FOV: 45 degrees · retinal fundus photograph.
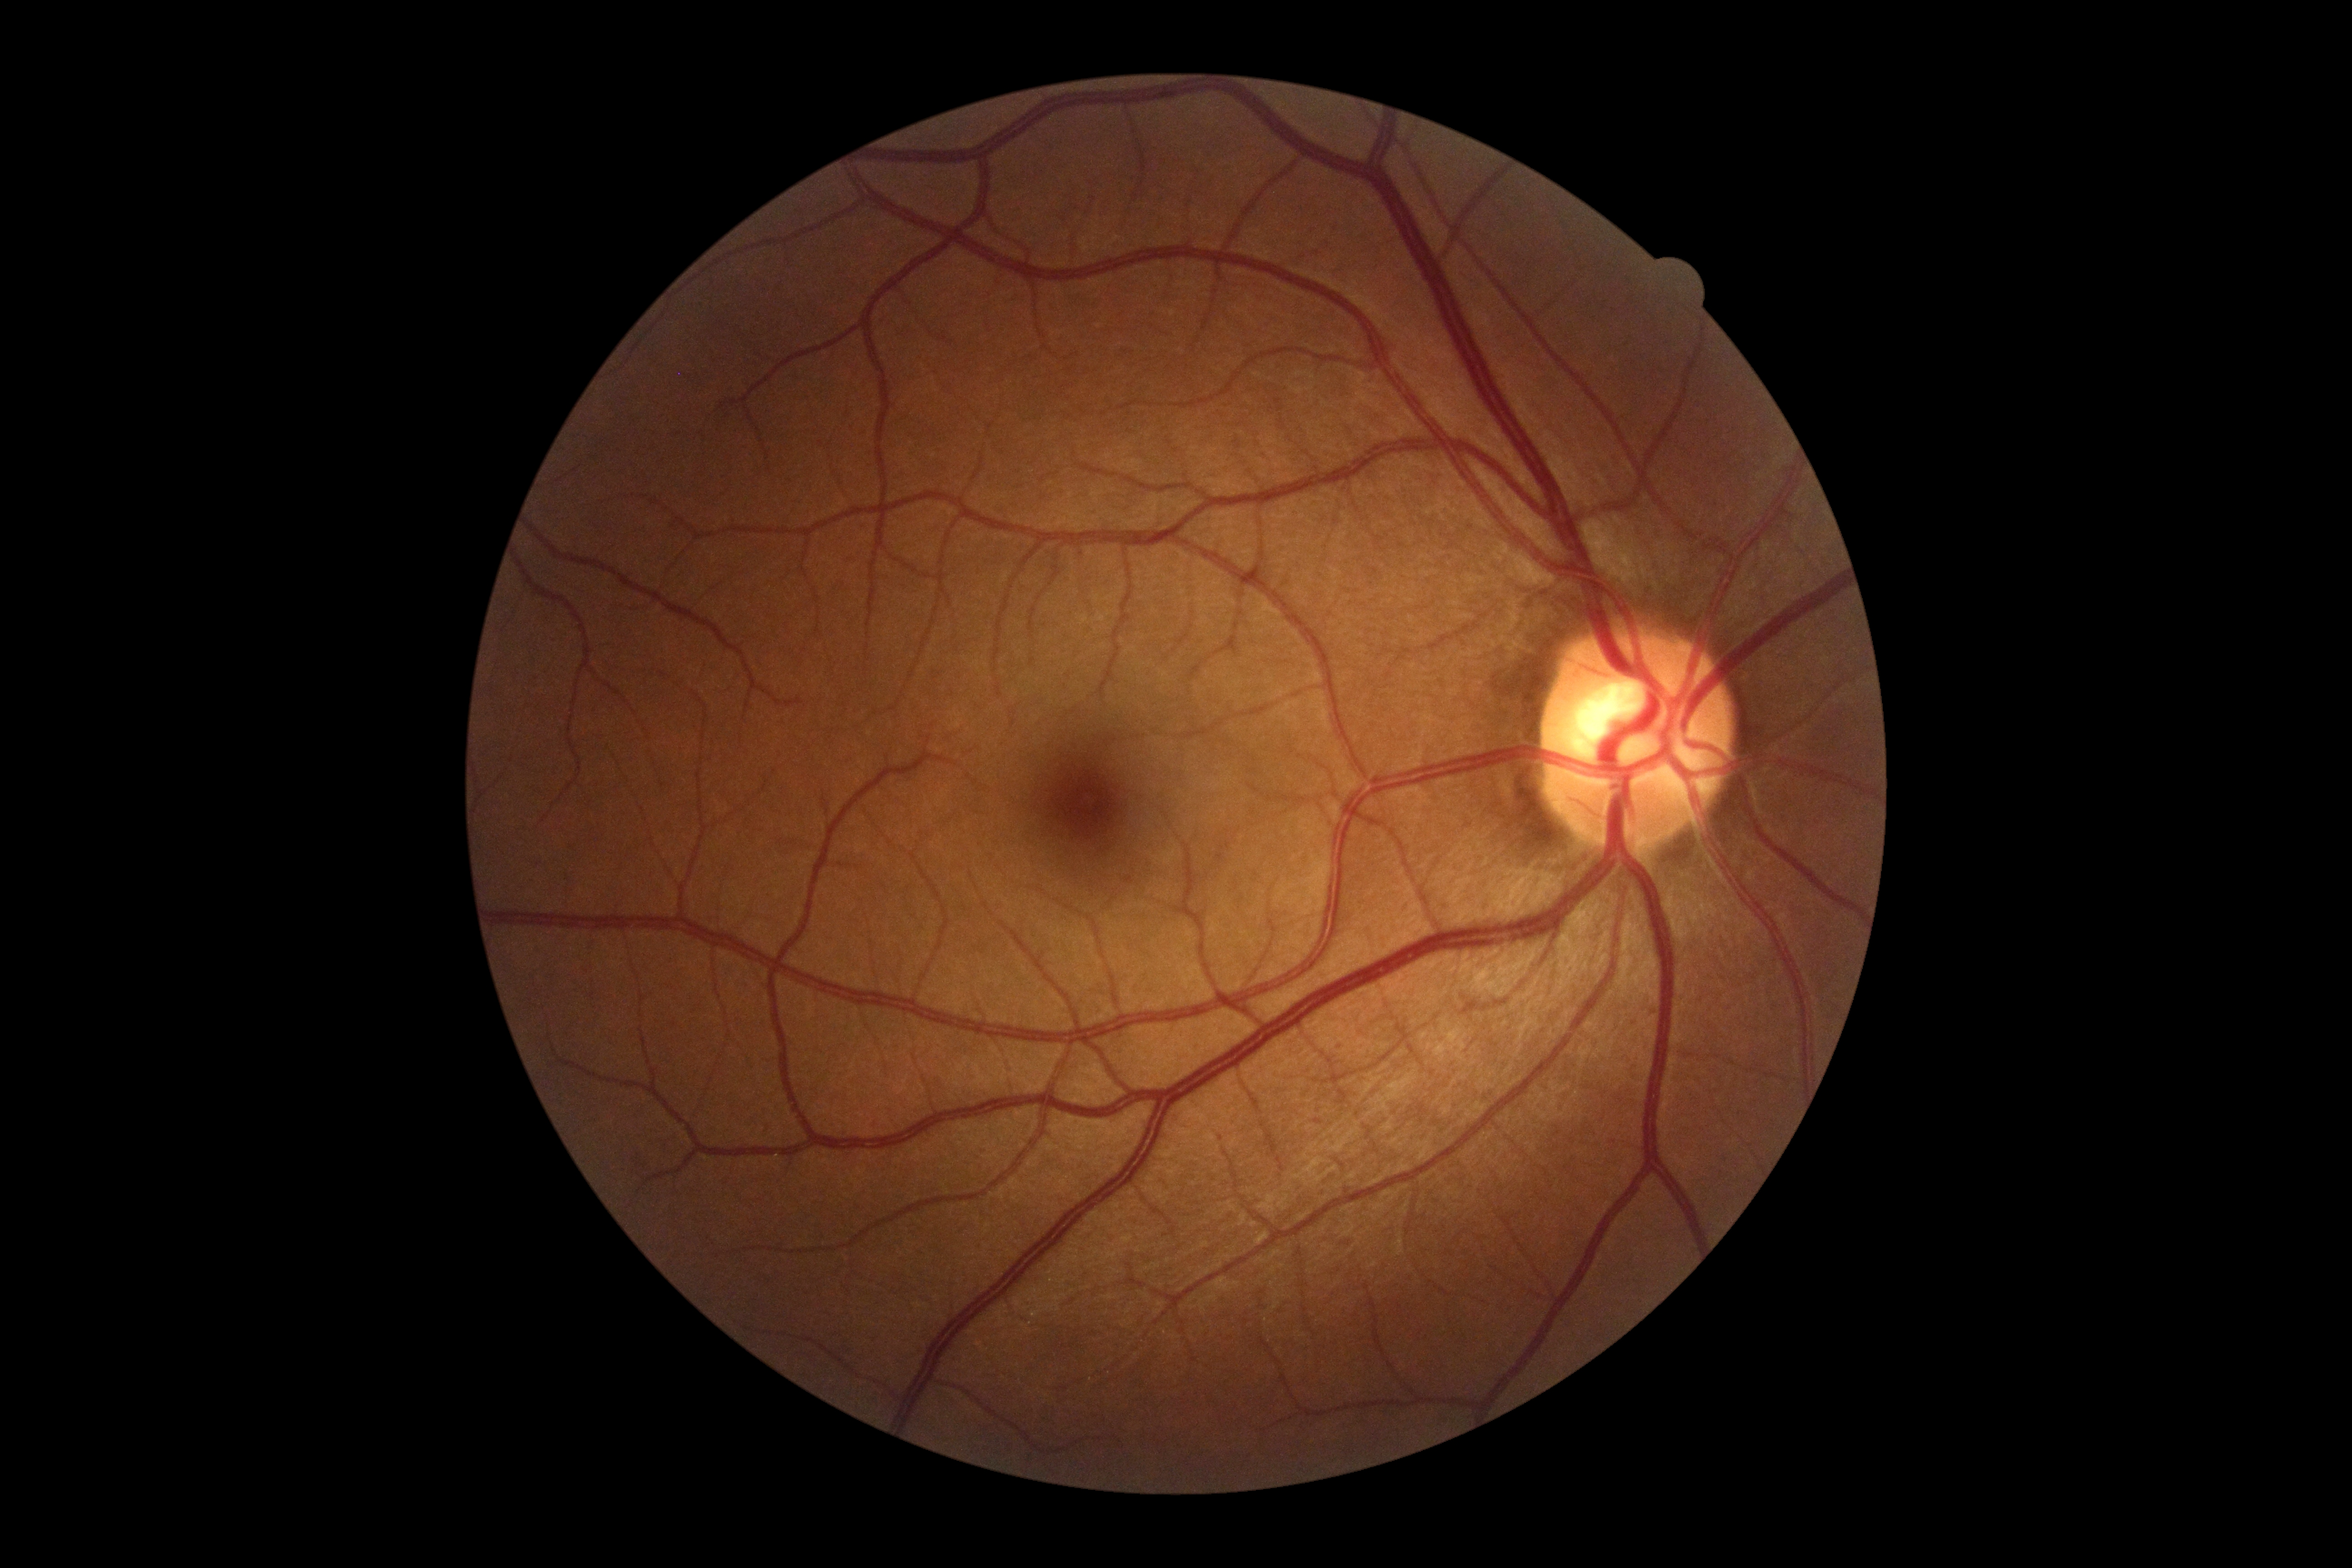
Diabetic retinopathy (DR) is grade 0 (no apparent retinopathy).